ONH-centered crop from a color fundus image
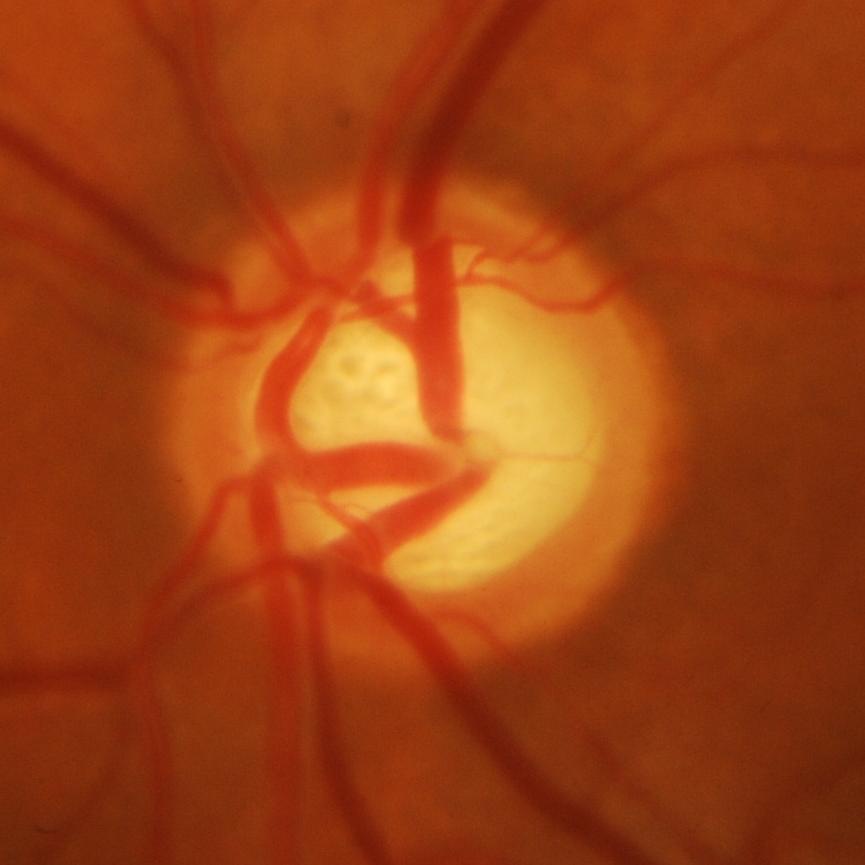
Showing evidence of glaucoma.